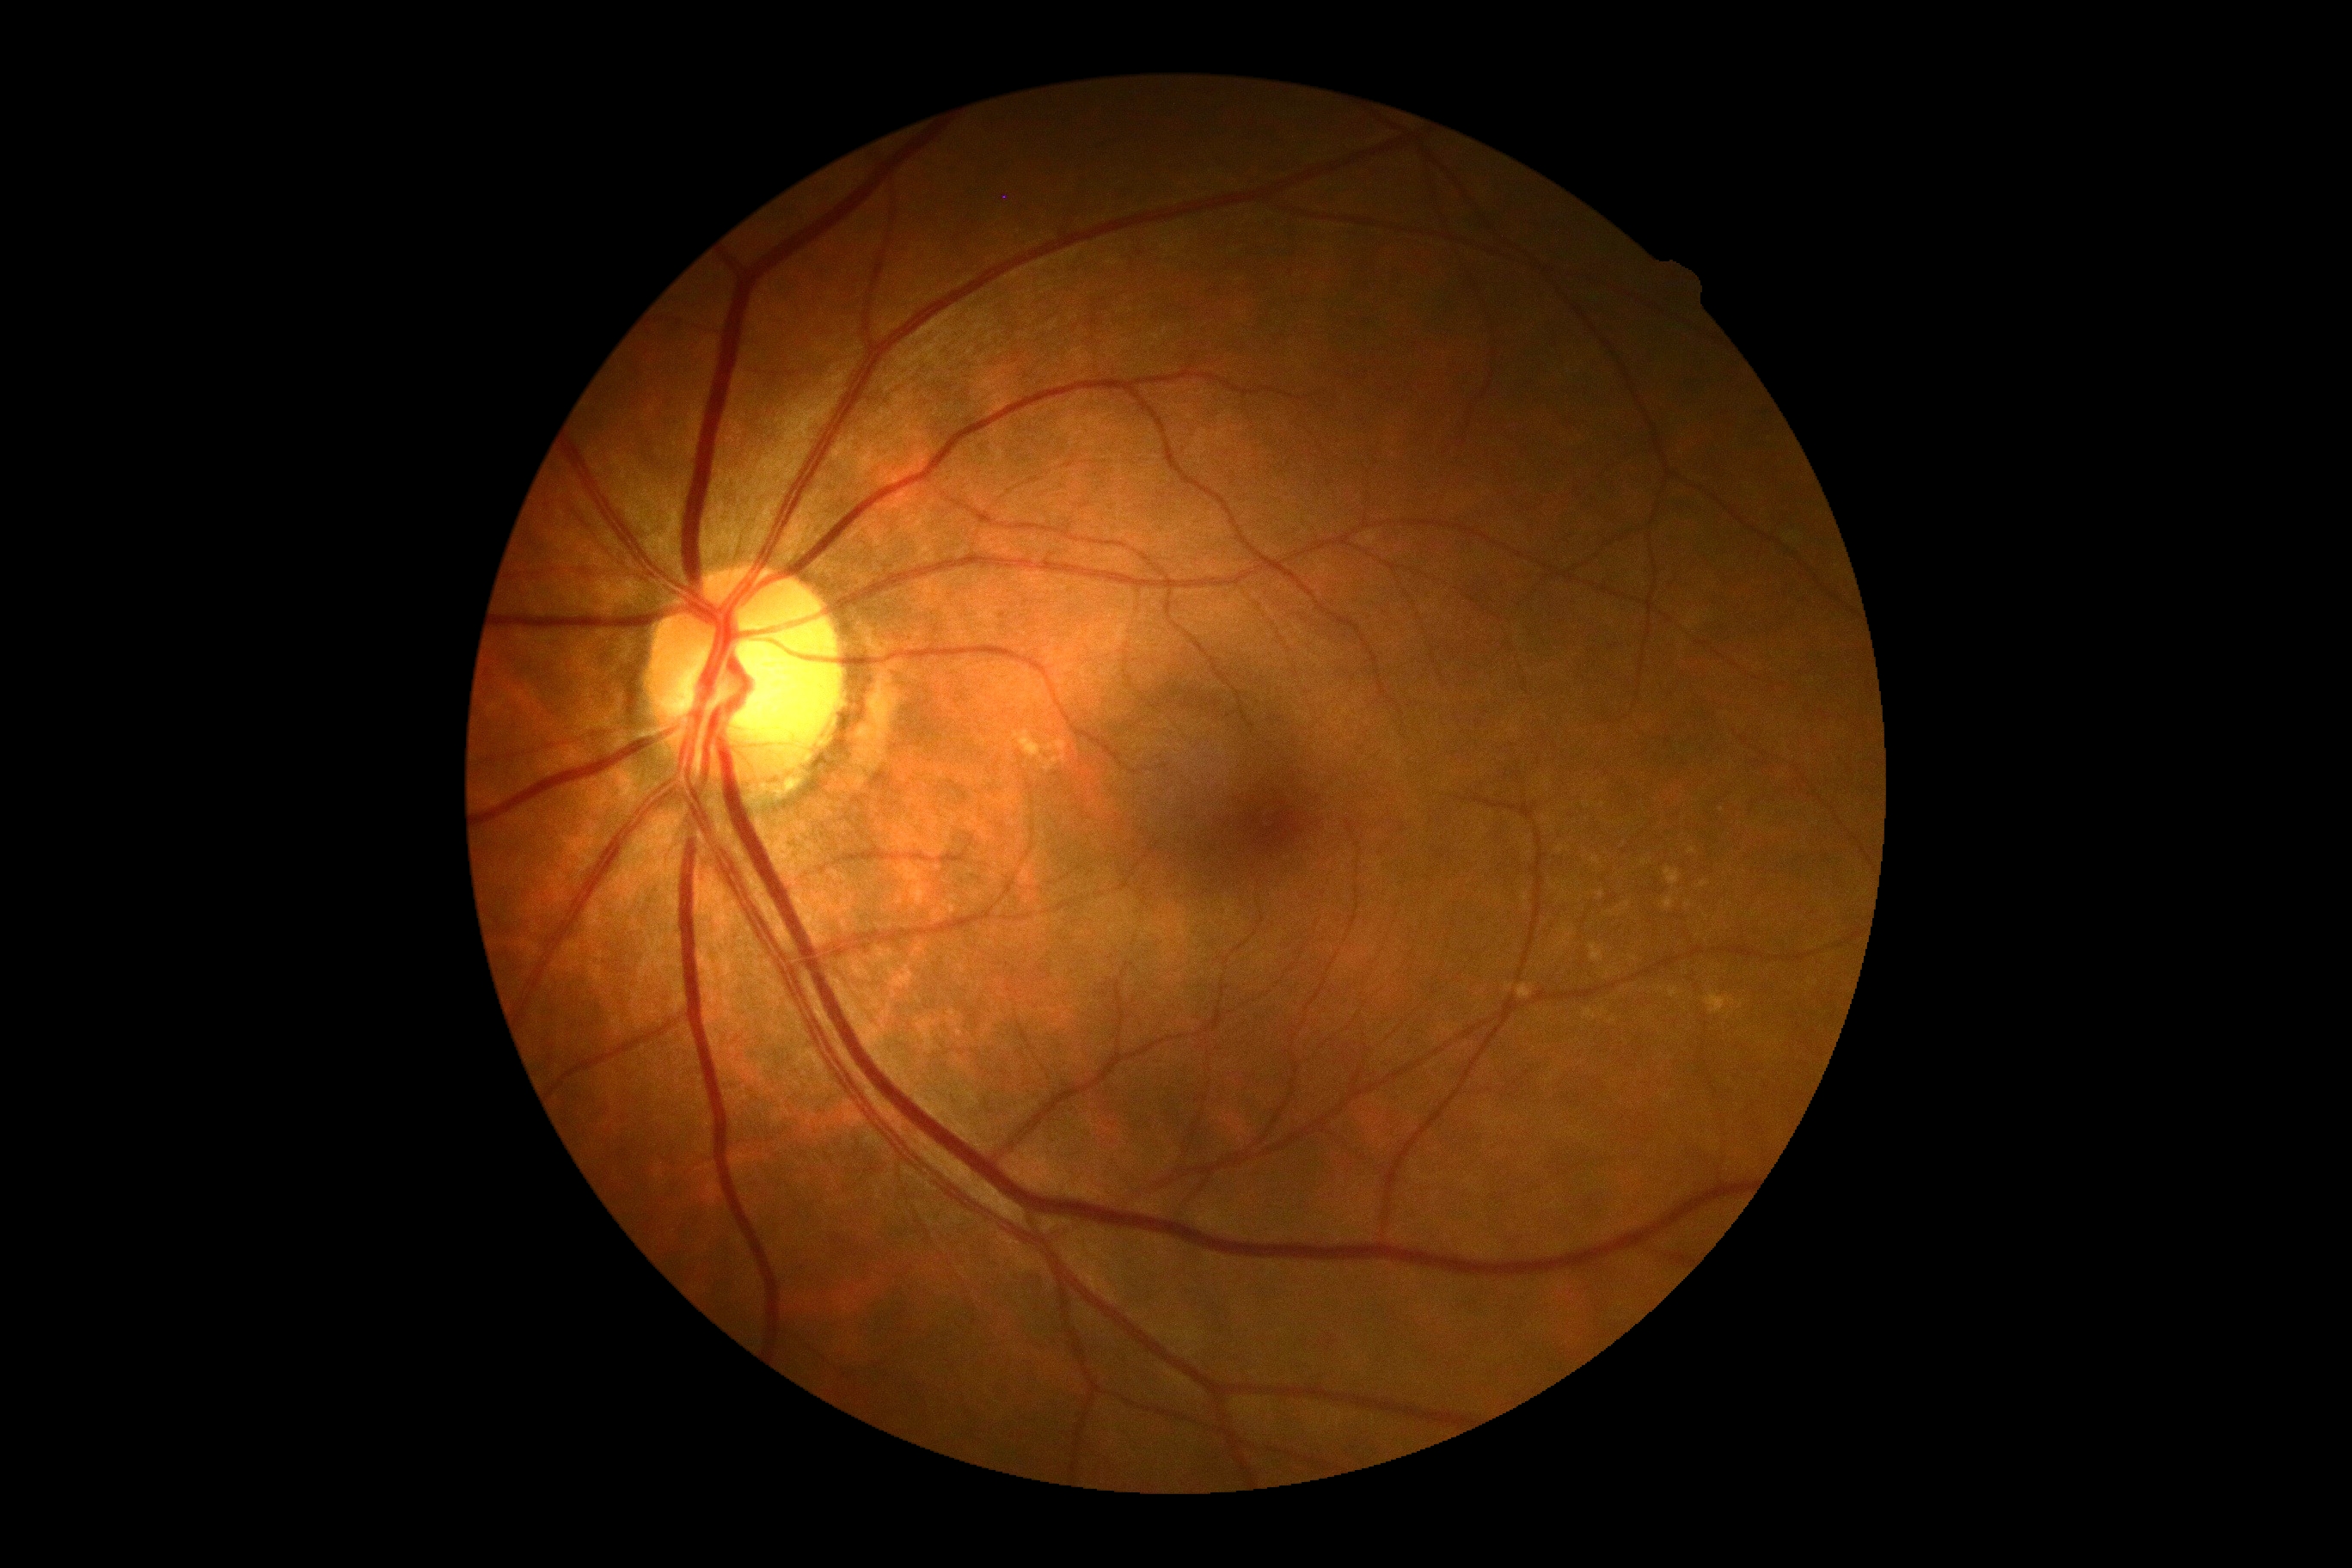

Findings:
• DR severity: grade 0 (no apparent retinopathy)